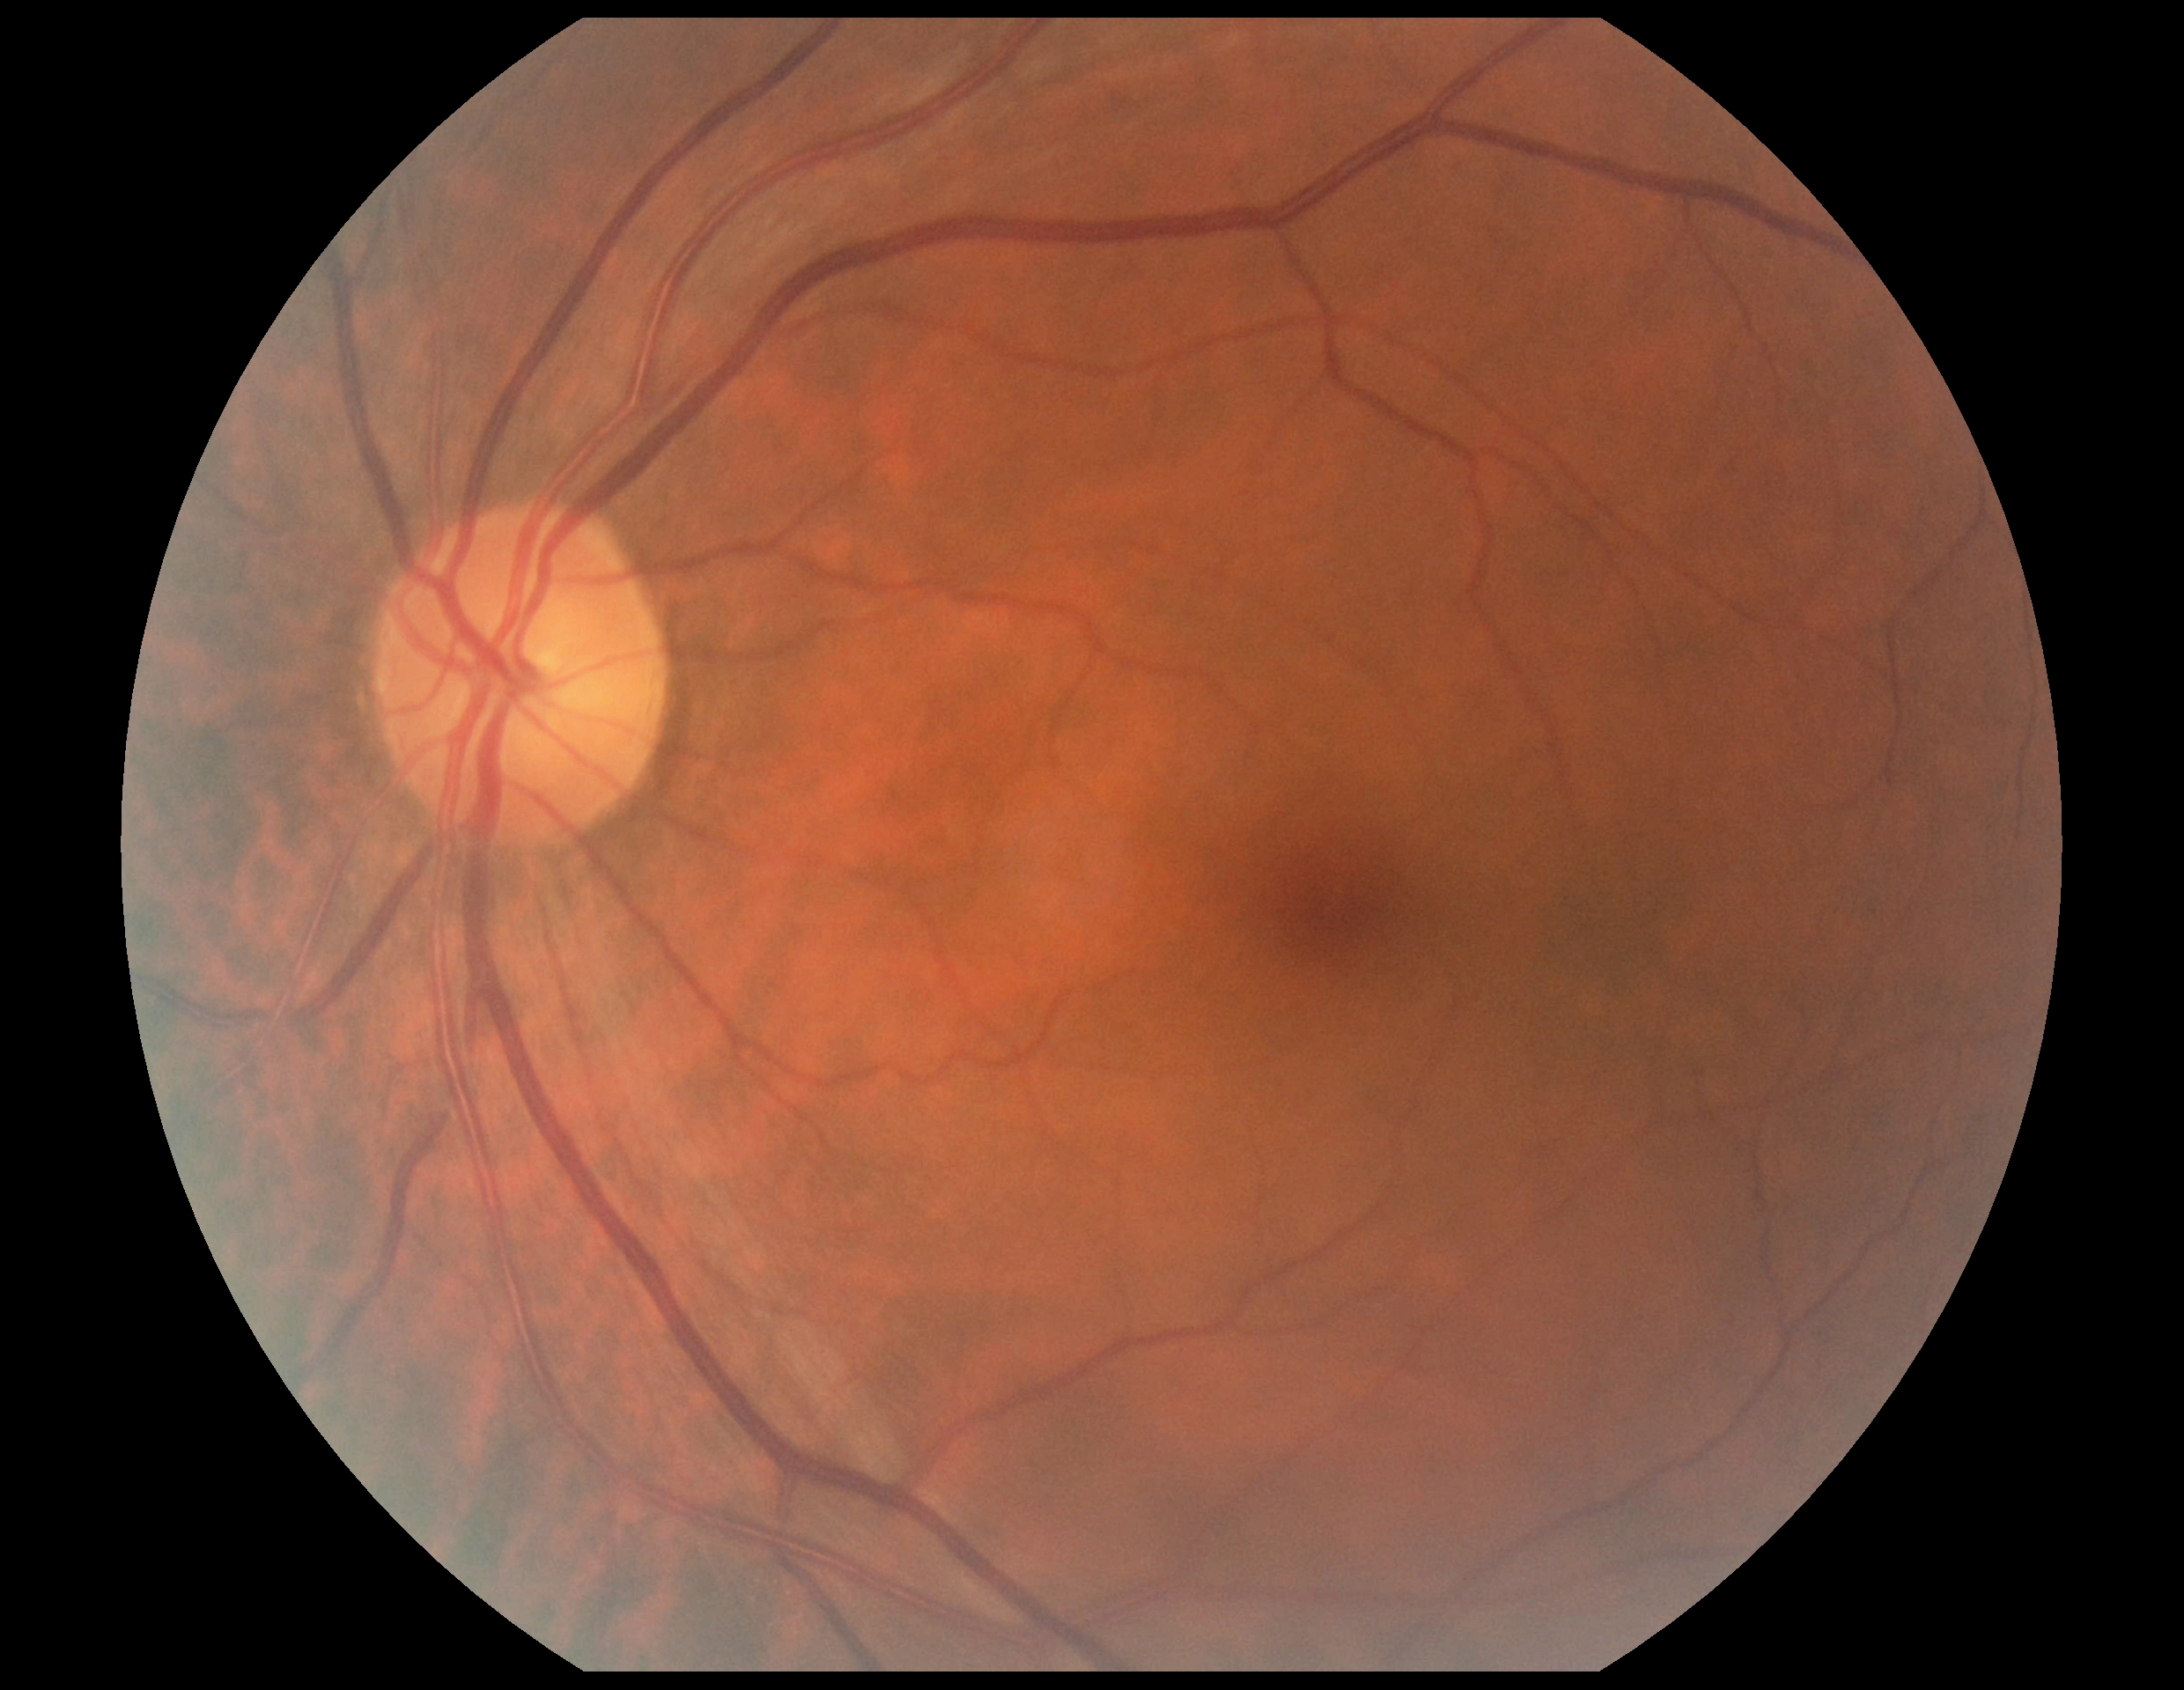 DR impression: negative for DR; diabetic retinopathy (DR): grade 0 (no apparent retinopathy).